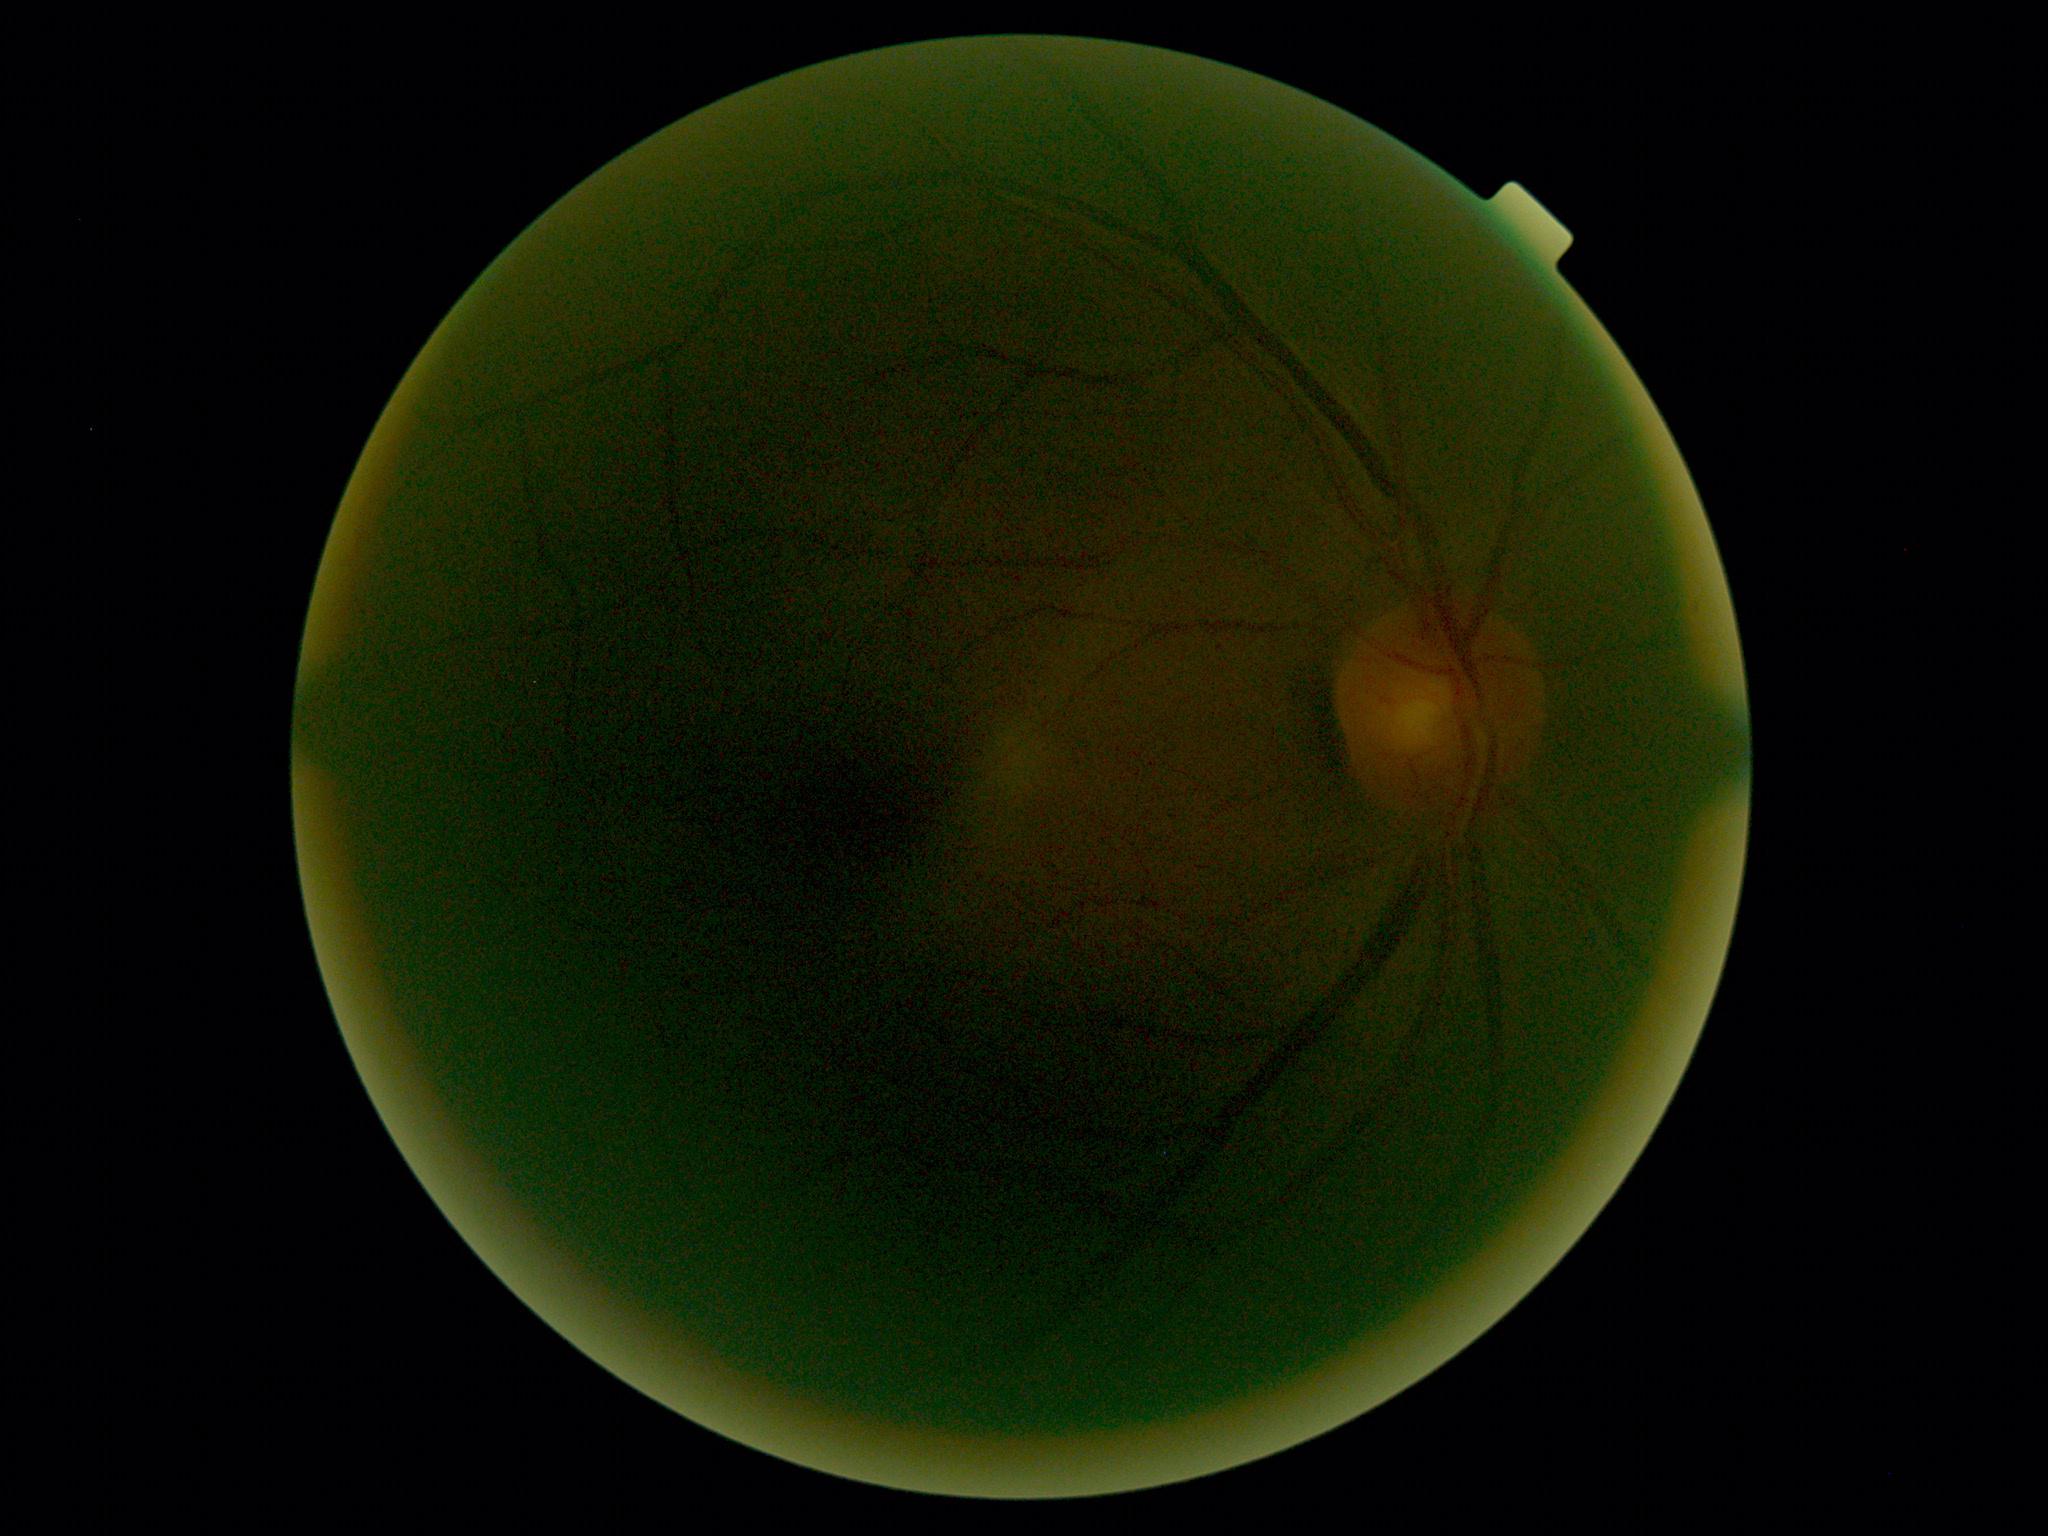 No apparent diabetic retinopathy. Diabetic retinopathy (DR): grade 0 (no apparent retinopathy).